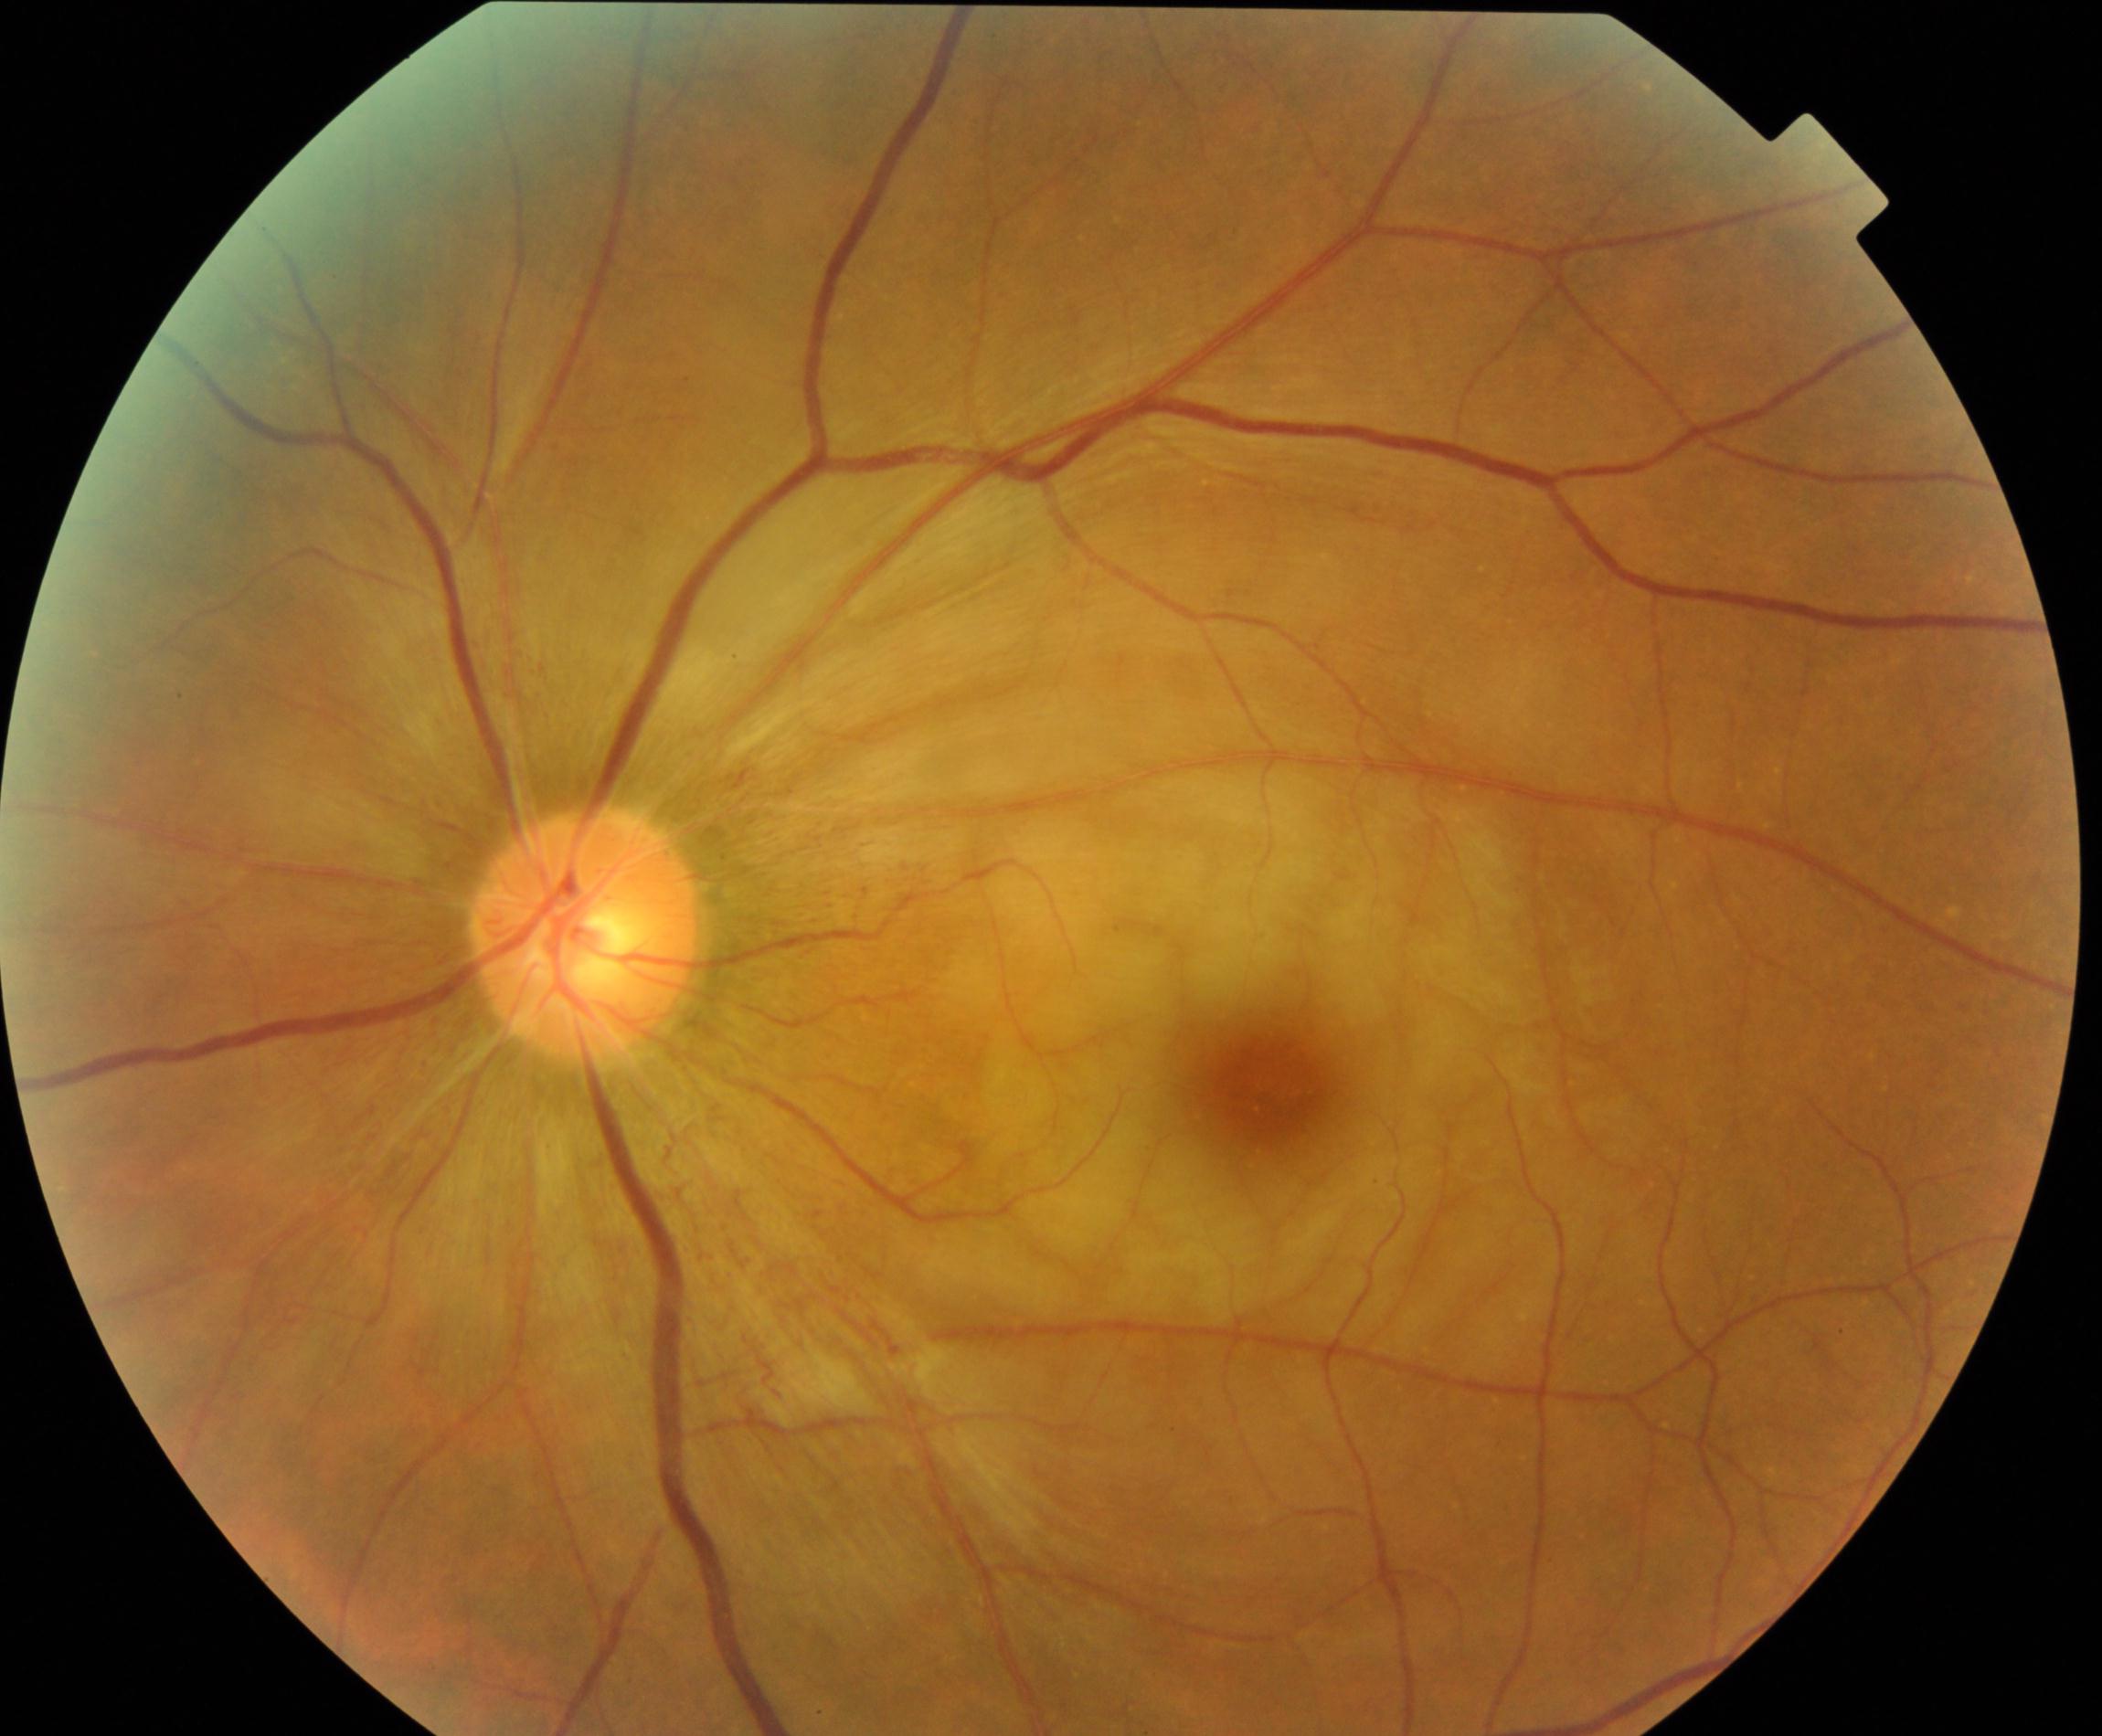 Findings consistent with retinal artery occlusion.